1240 by 1240 pixels. Phoenix ICON wide-field infant fundus image
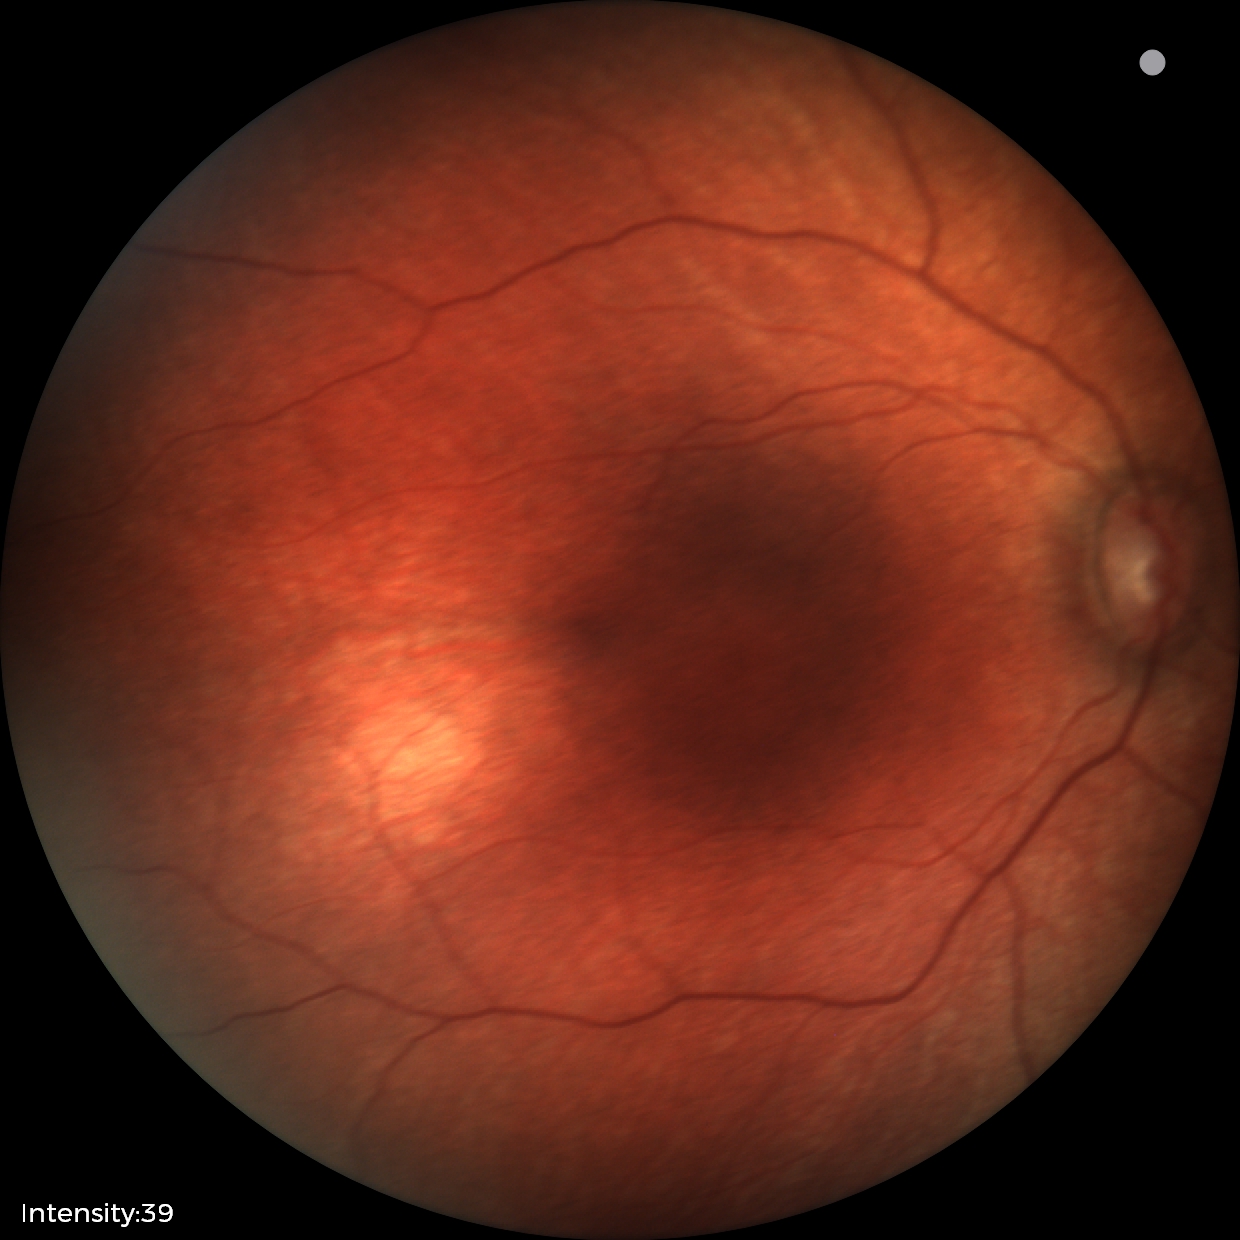
Normal screening examination.